FOV: 45 degrees — 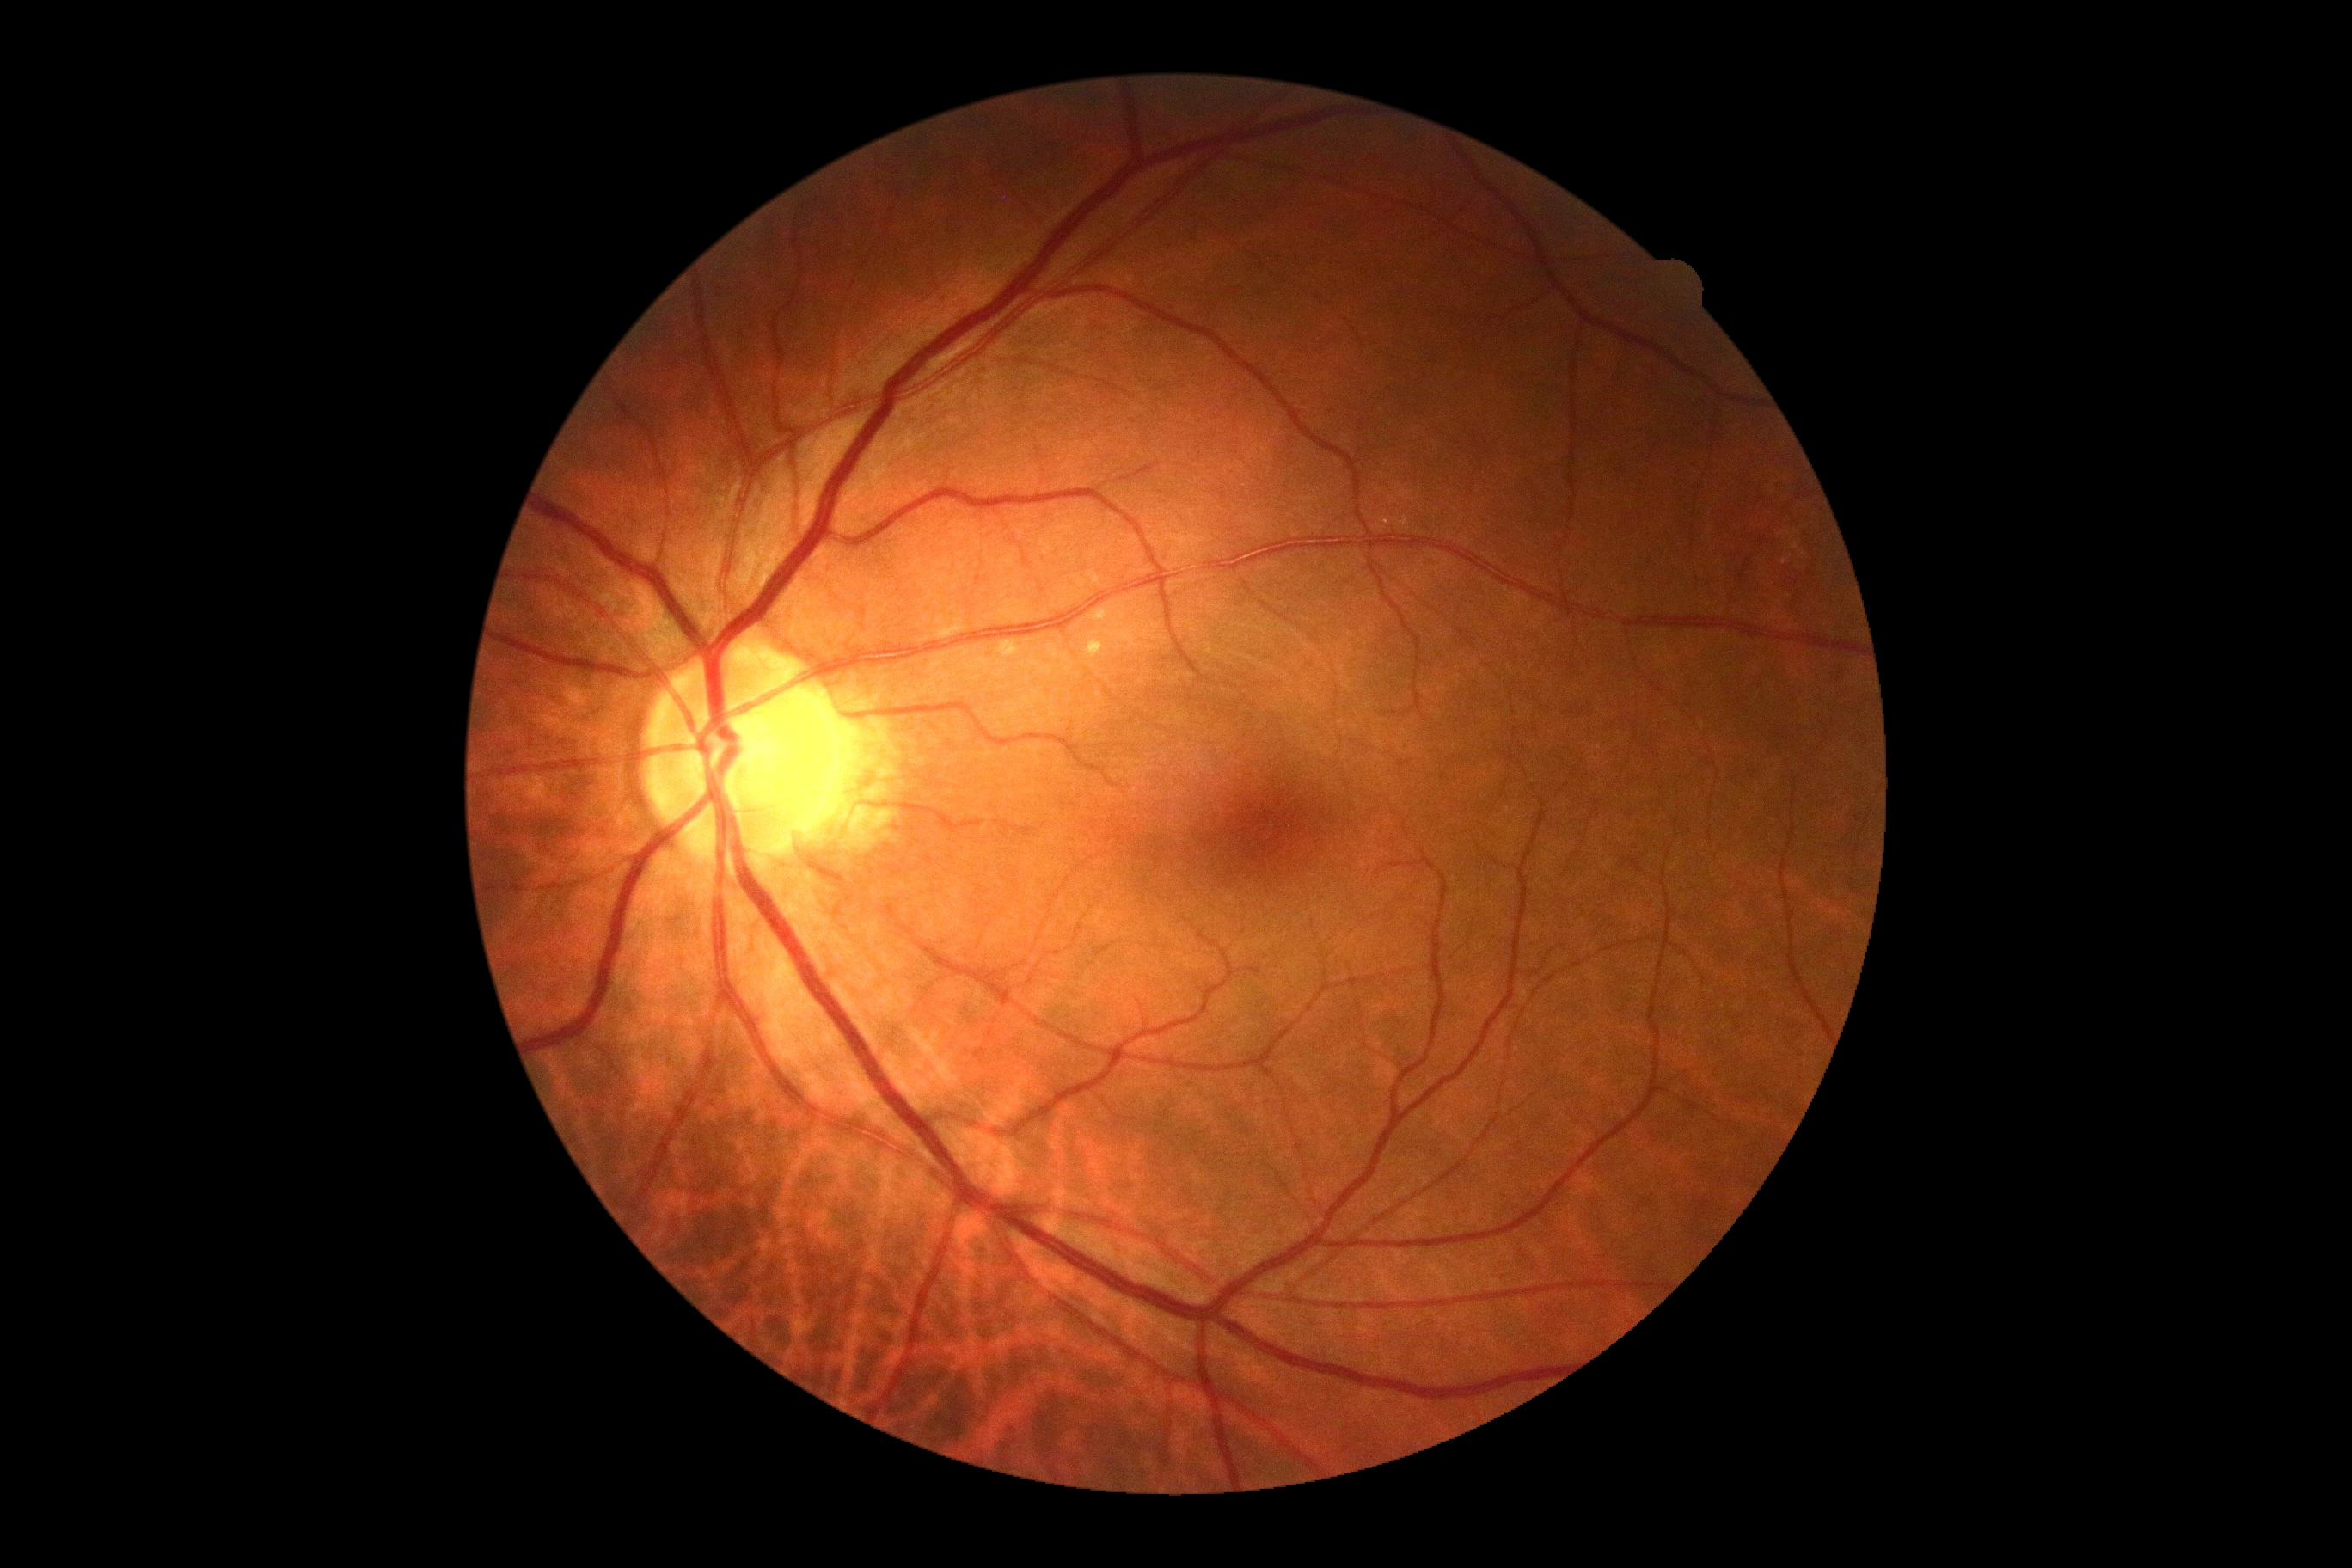

Diabetic retinopathy is grade 0 (no apparent retinopathy).